CFP:
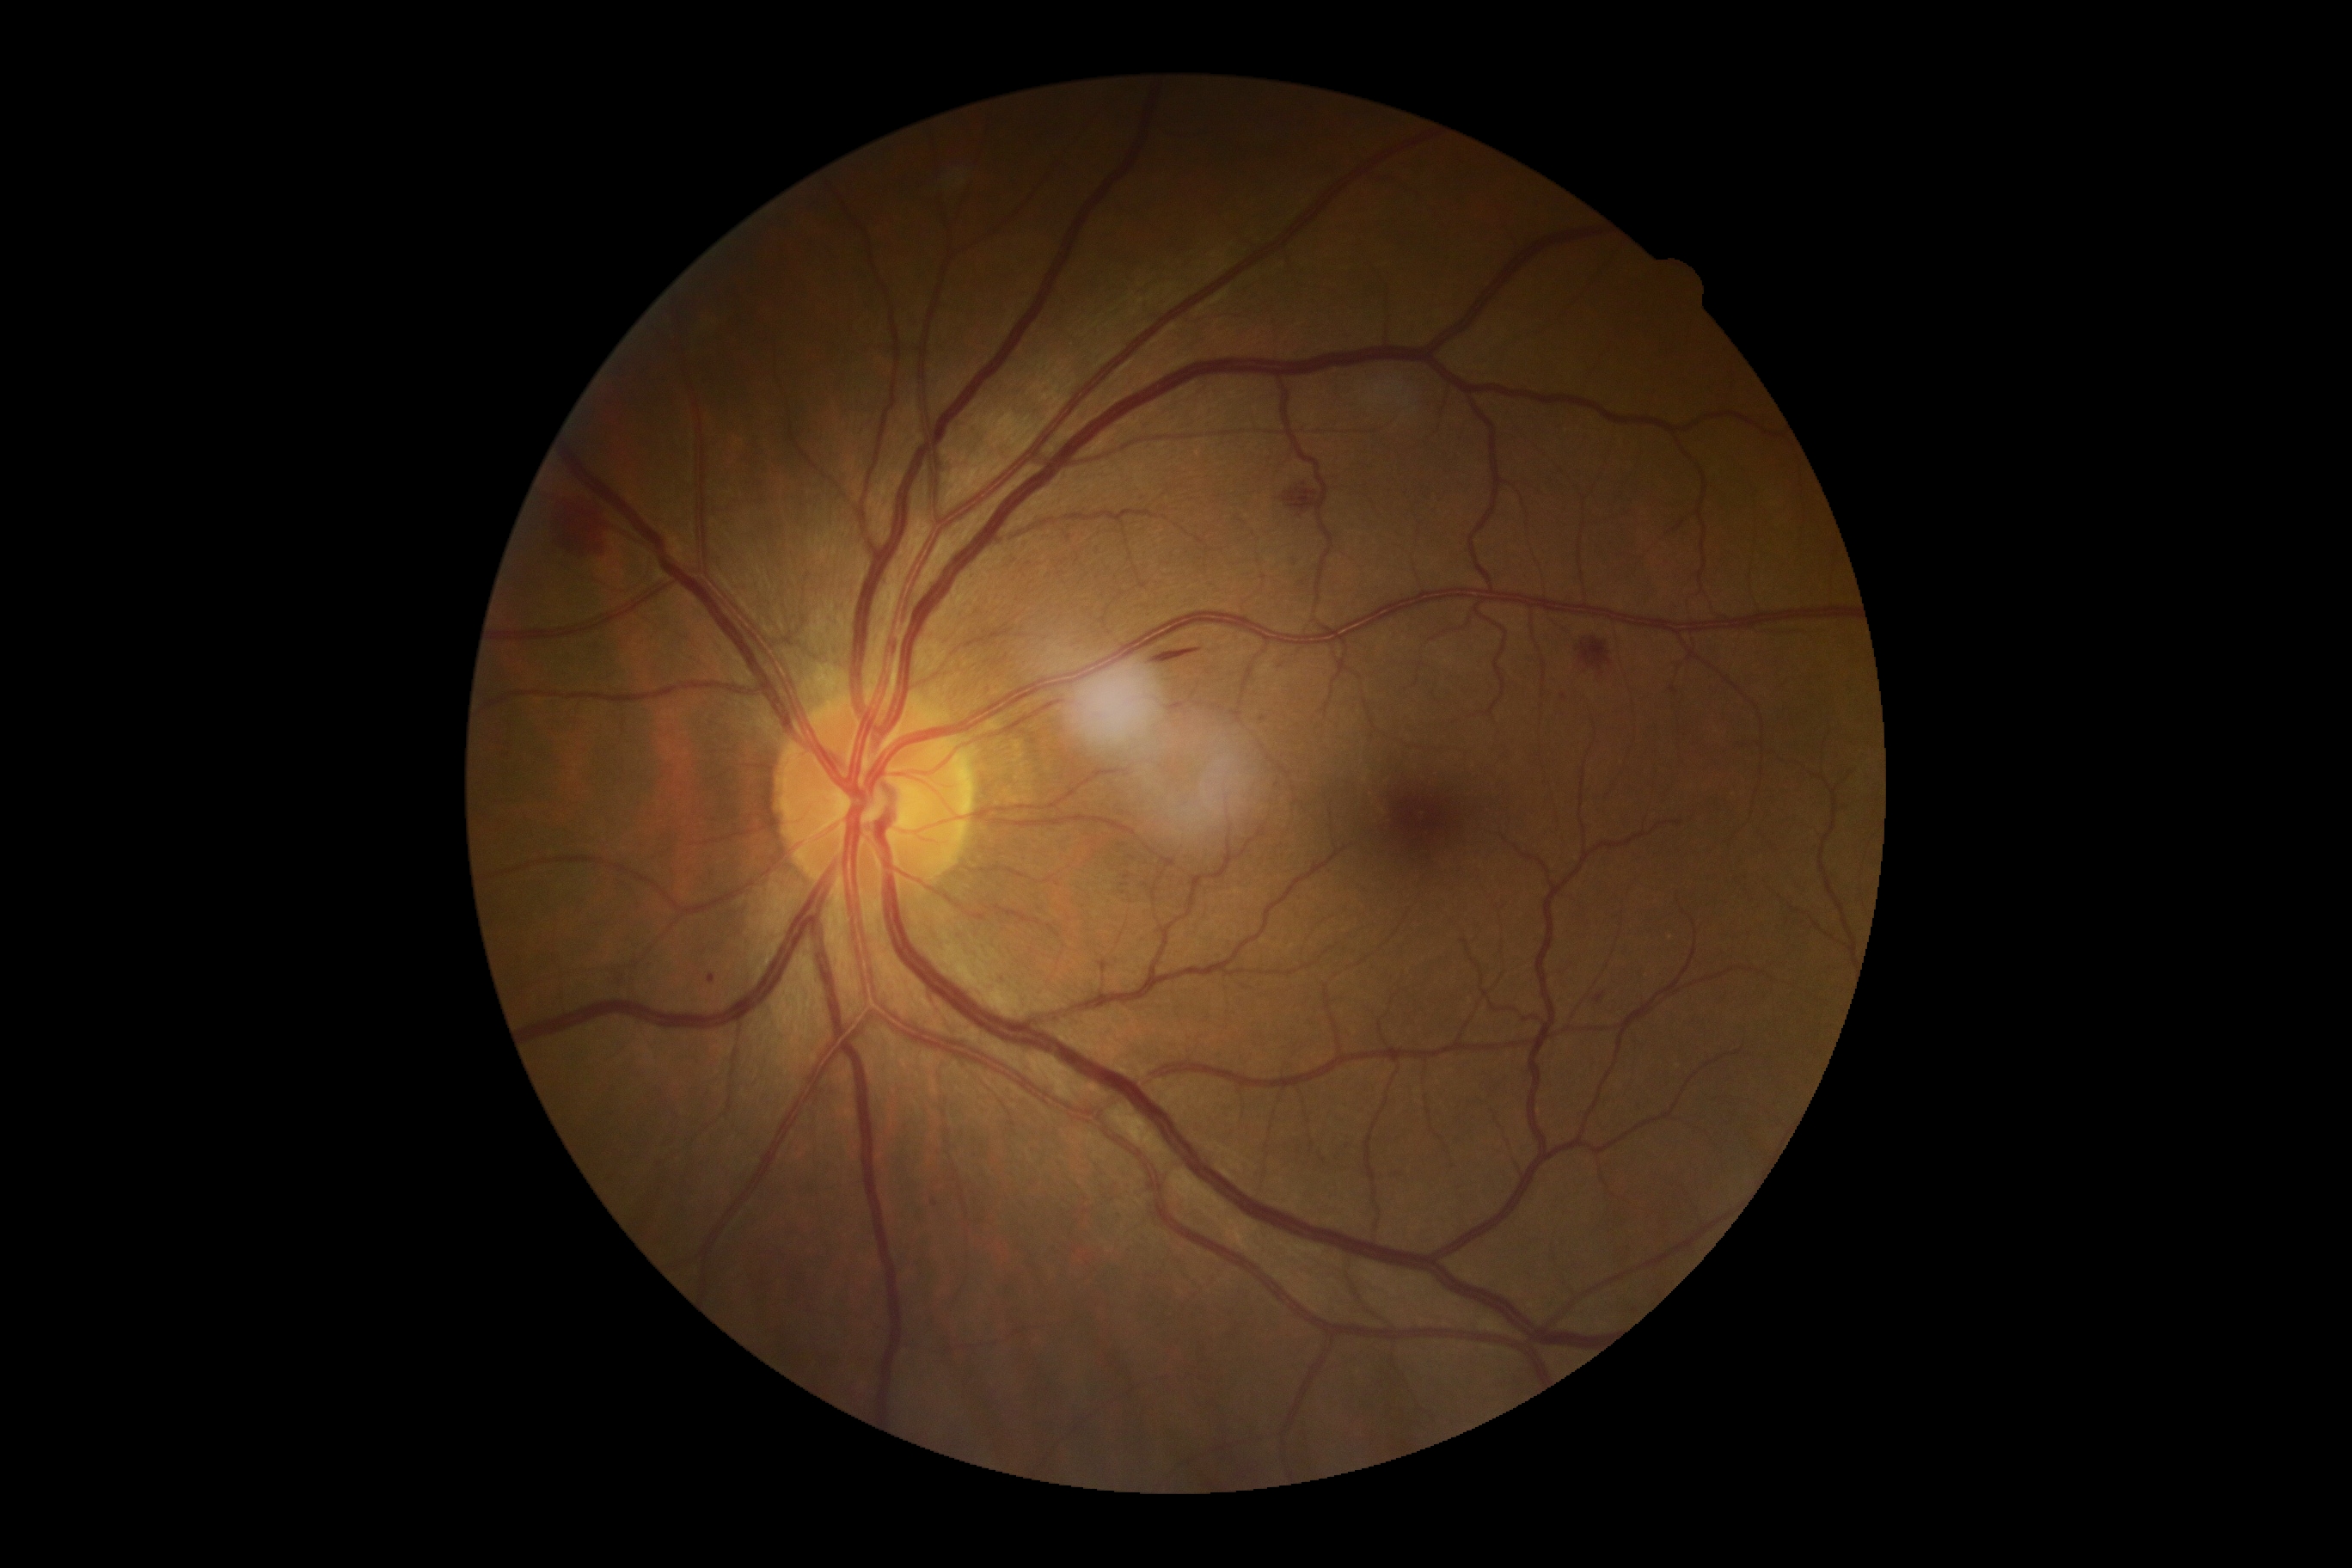
DR severity: grade 2 (moderate NPDR).